Modified Davis classification. Nonmydriatic fundus photograph
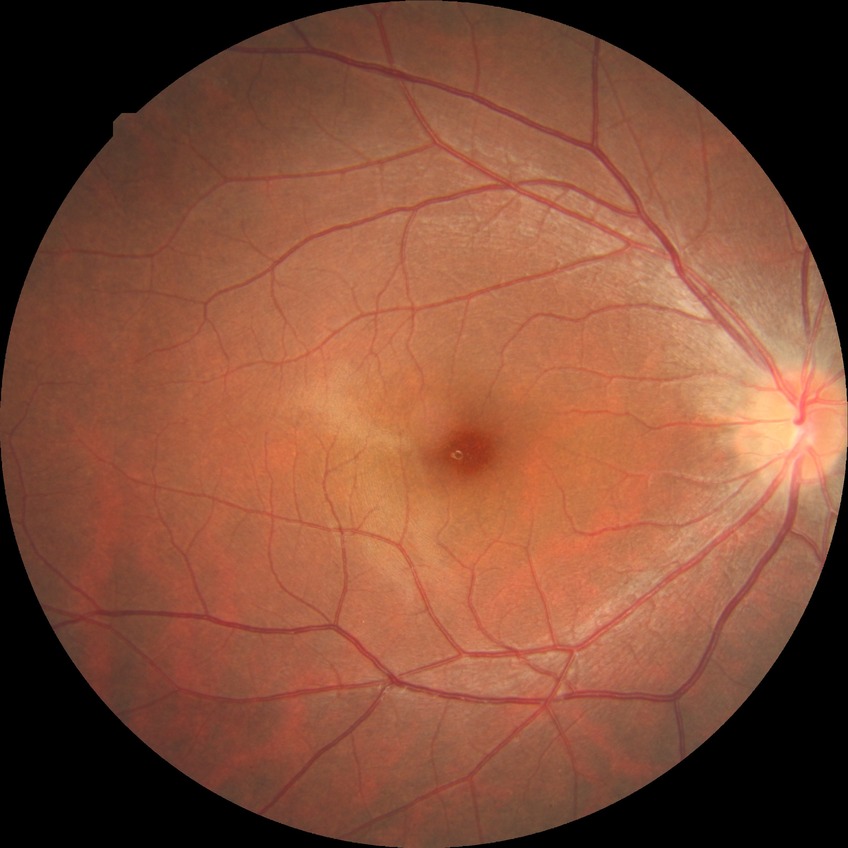
Modified Davis grading is no diabetic retinopathy.